2212x1659px: 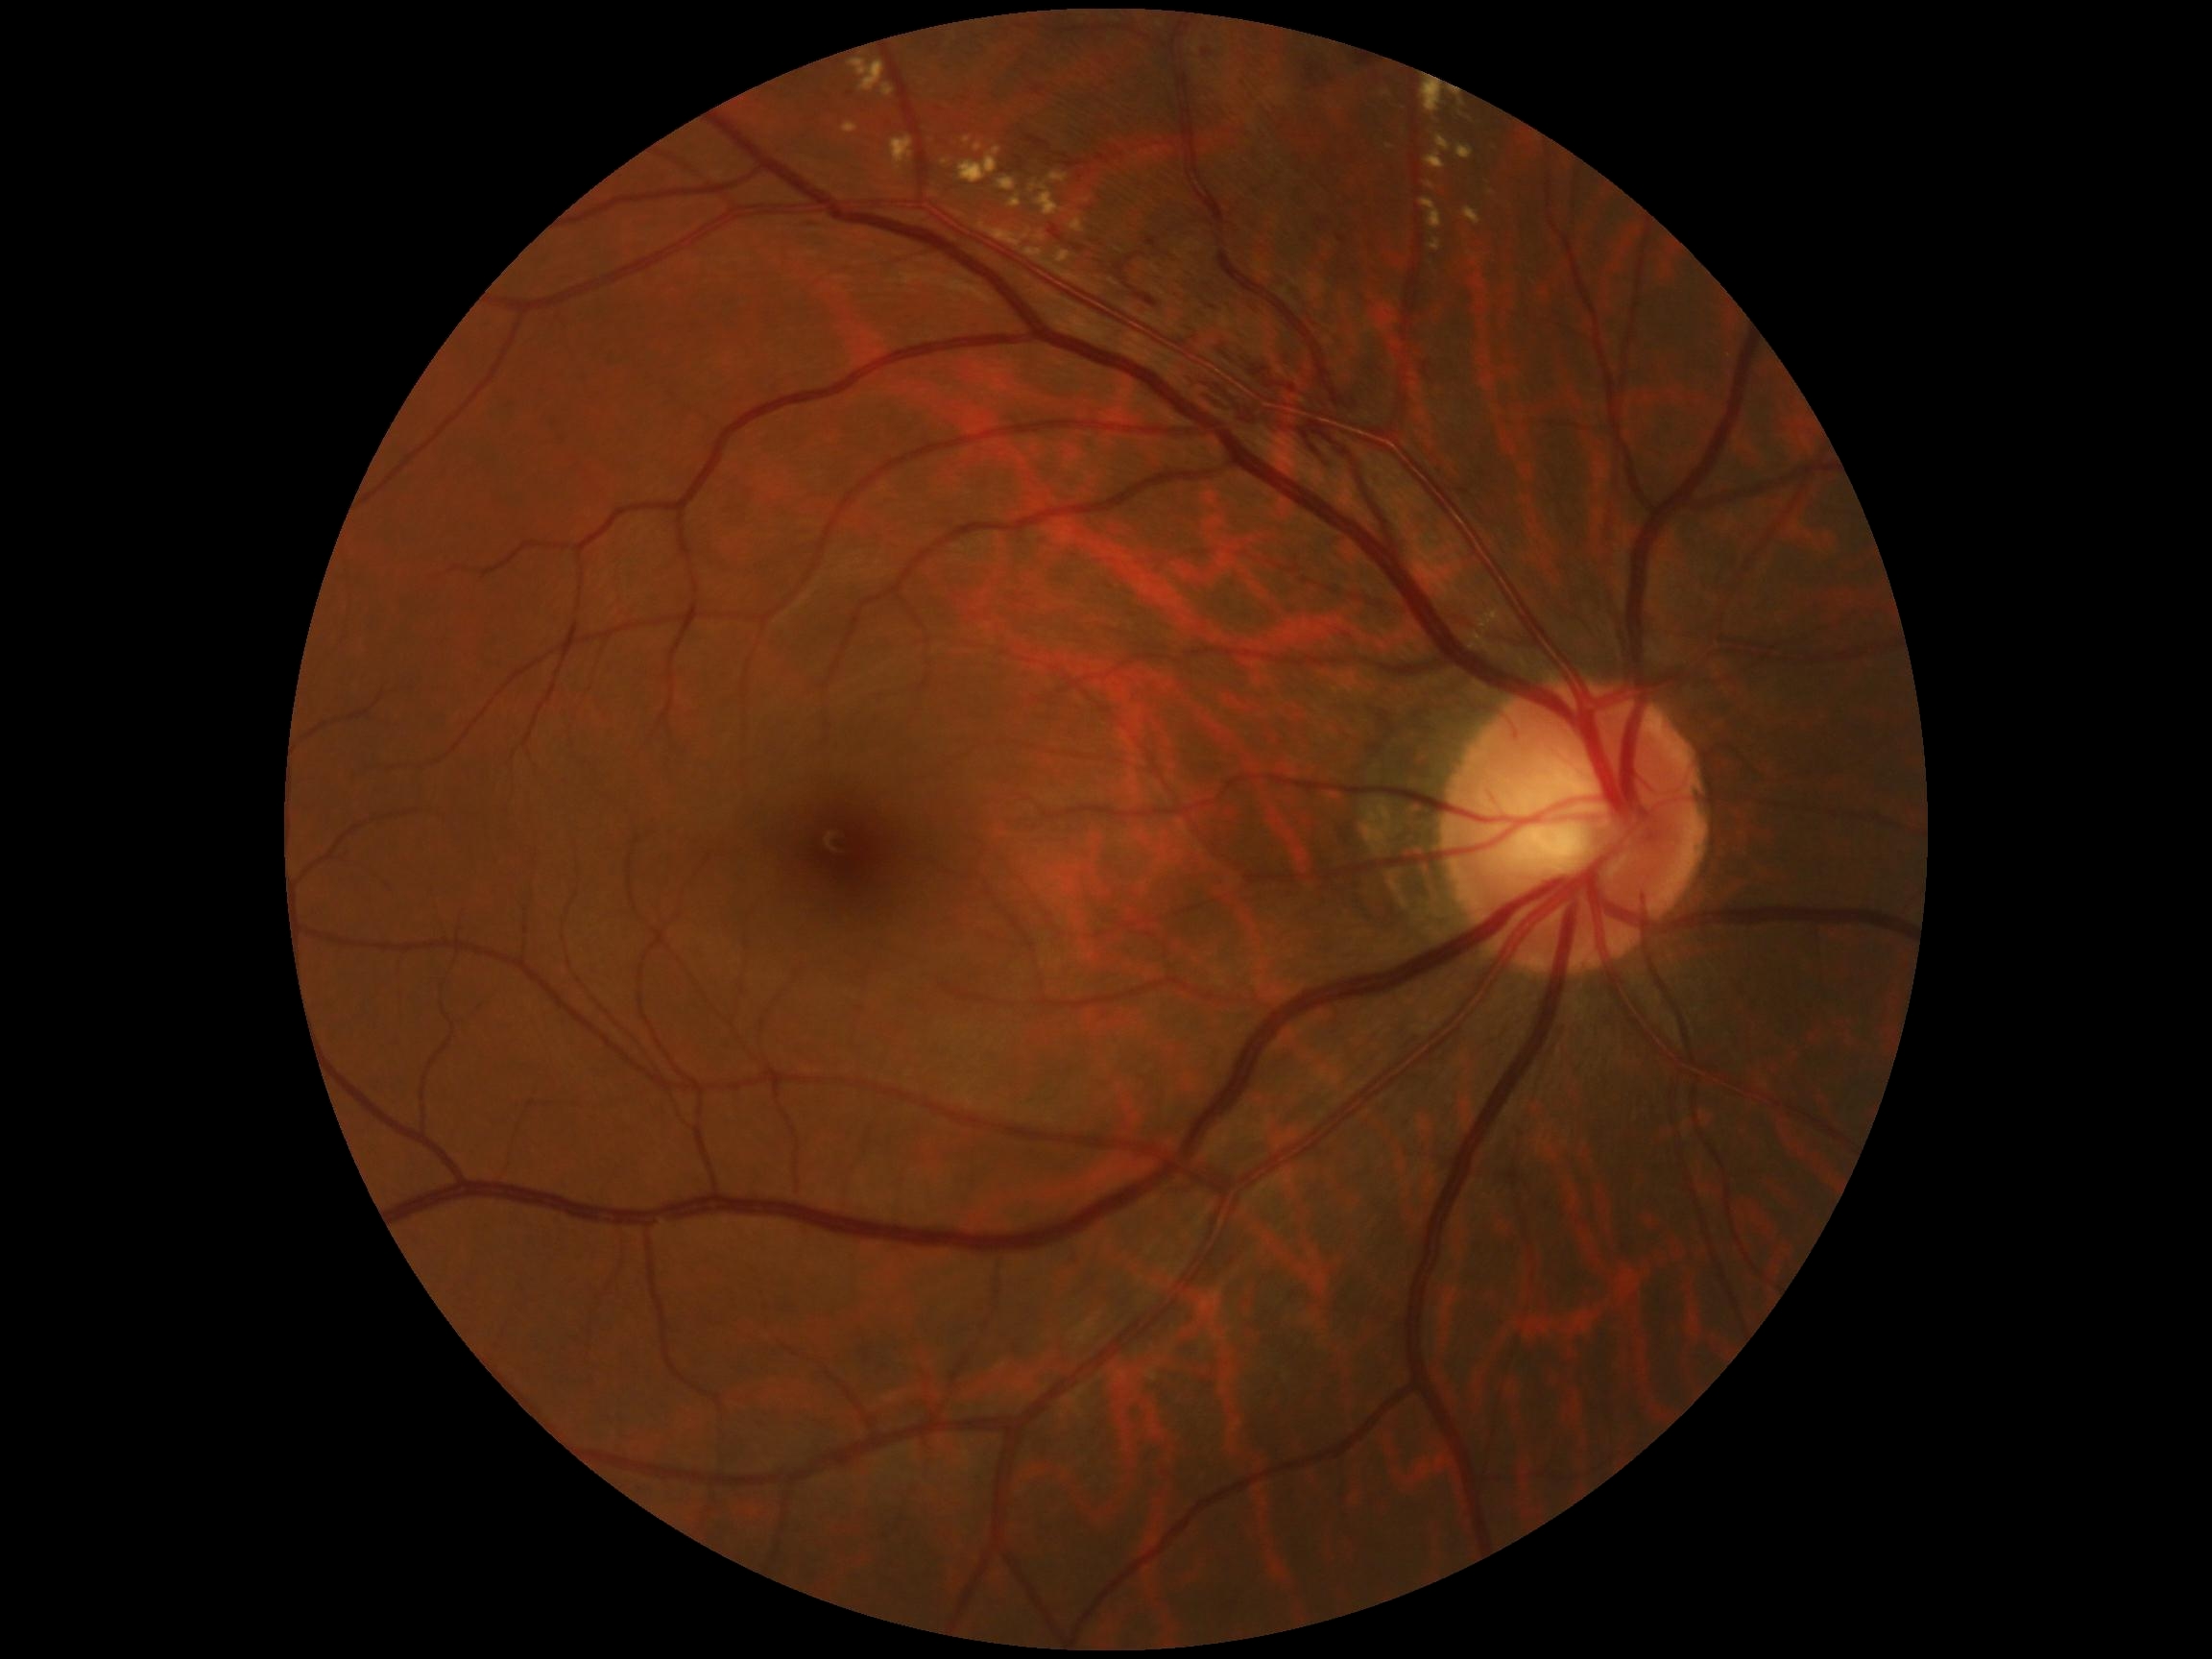

Diabetic retinopathy (DR): 2
A subset of detected lesions:
hard exudates (EXs) (continued): (left=1048, top=173, right=1069, bottom=183); (left=942, top=159, right=950, bottom=166); (left=842, top=123, right=858, bottom=134); (left=1426, top=152, right=1446, bottom=171); (left=1421, top=200, right=1443, bottom=230); (left=1453, top=95, right=1472, bottom=121); (left=1429, top=240, right=1441, bottom=252); (left=980, top=224, right=1021, bottom=248); (left=974, top=143, right=984, bottom=152); (left=851, top=57, right=886, bottom=92); (left=1464, top=207, right=1481, bottom=226); (left=1056, top=252, right=1072, bottom=264); (left=1436, top=135, right=1451, bottom=152)
Small EXs approximately at [x=1390, y=147]; [x=1042, y=238]
hemorrhages (HEs) (continued): (left=1147, top=238, right=1157, bottom=248); (left=803, top=217, right=830, bottom=228); (left=1064, top=161, right=1090, bottom=169); (left=1358, top=58, right=1373, bottom=66); (left=1073, top=246, right=1083, bottom=252); (left=1202, top=51, right=1214, bottom=57); (left=1127, top=252, right=1144, bottom=262); (left=1120, top=278, right=1159, bottom=307); (left=1194, top=376, right=1264, bottom=426); (left=1049, top=226, right=1064, bottom=243)
Small HEs approximately at [x=1324, y=223]